Diabetic retinopathy graded by the modified Davis classification; 45° FOV:
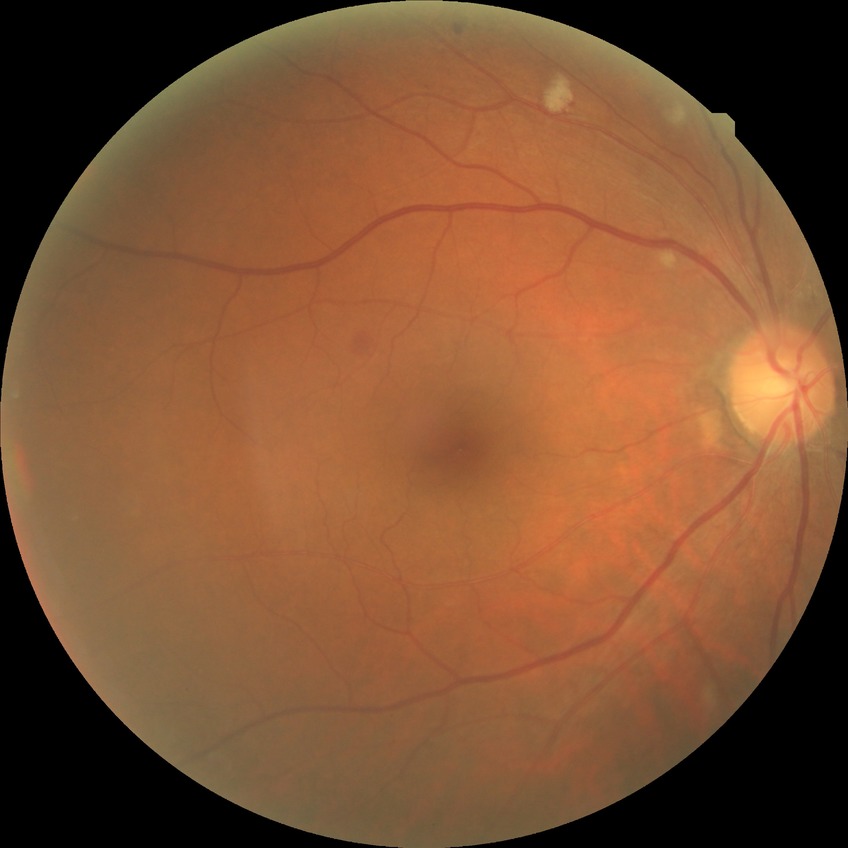

Davis grading = pre-proliferative diabetic retinopathy.